1659x2212 · acquired with a Remidio Fundus on Phone (FOP) camera · color fundus image: 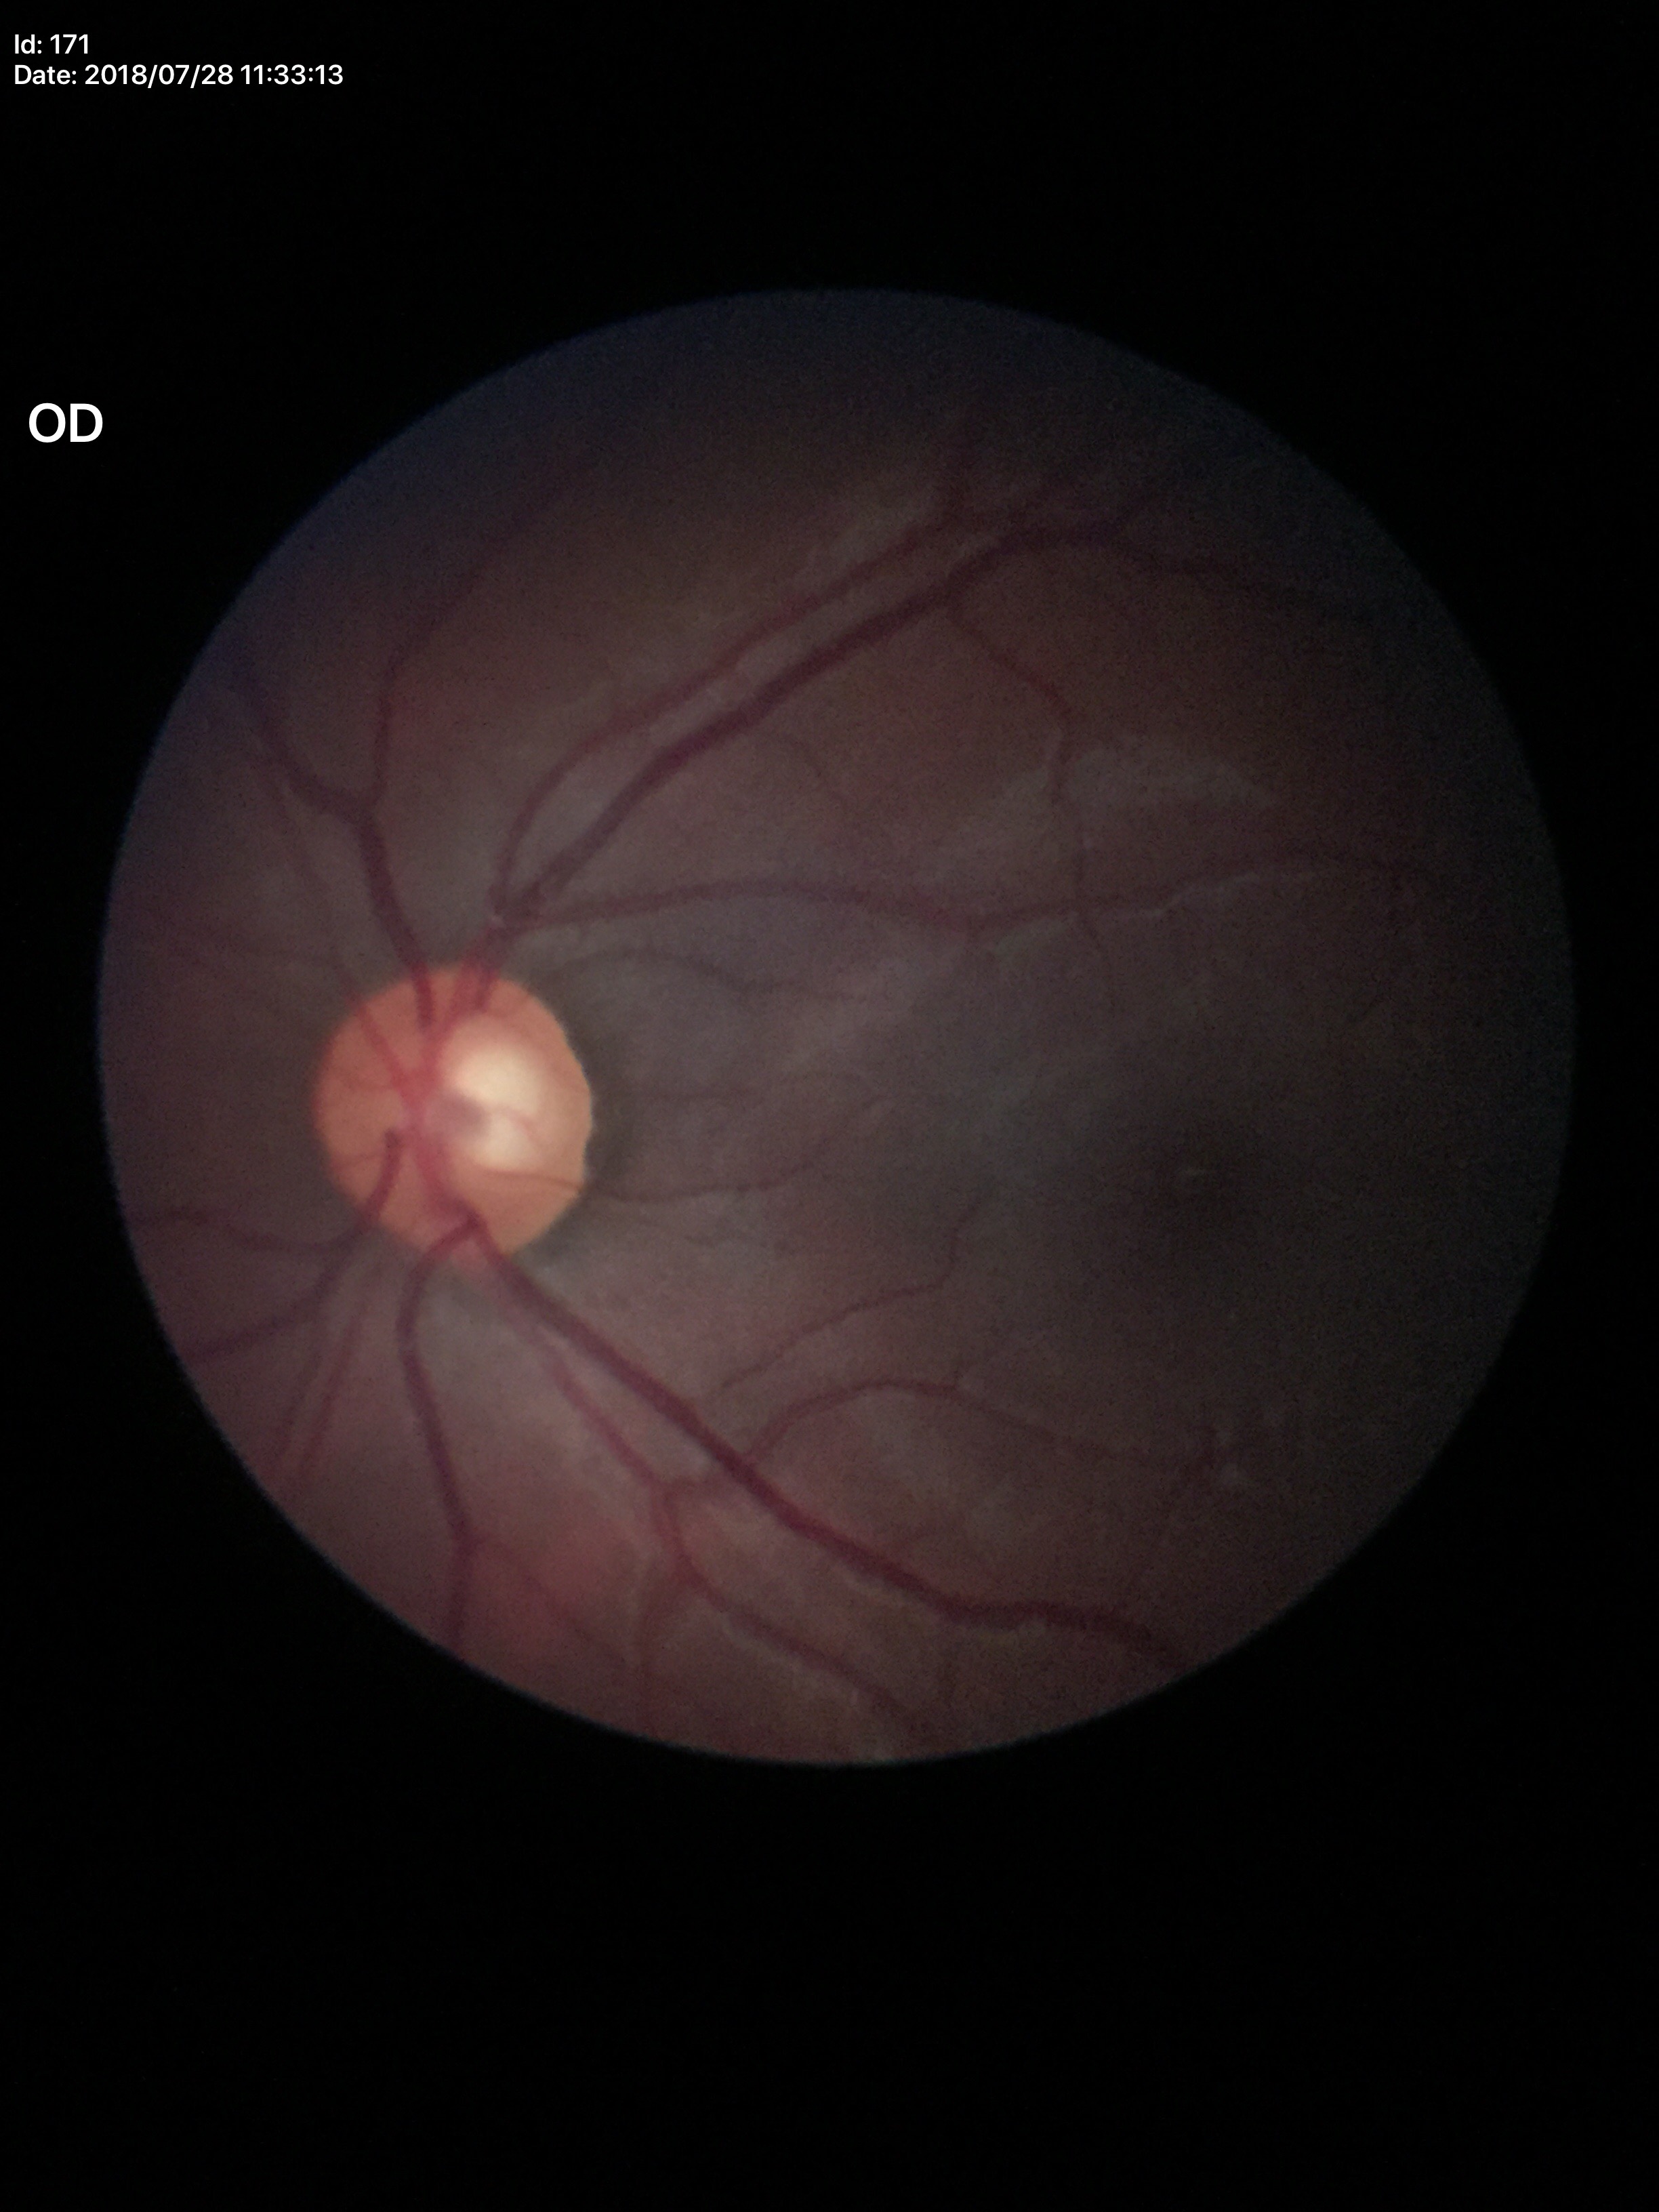
Glaucoma evaluation: negative. Vertical cup-disc ratio (VCDR) of 0.60.